Camera: Clarity RetCam 3 (130° FOV) · infant wide-field retinal image
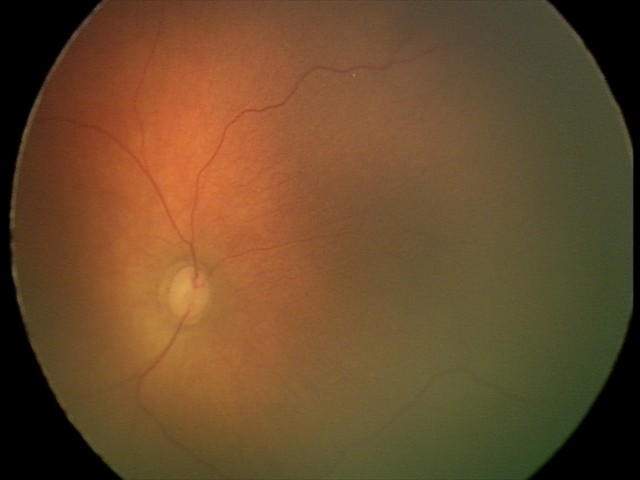
Diagnosis: no abnormalities.